848x848px: 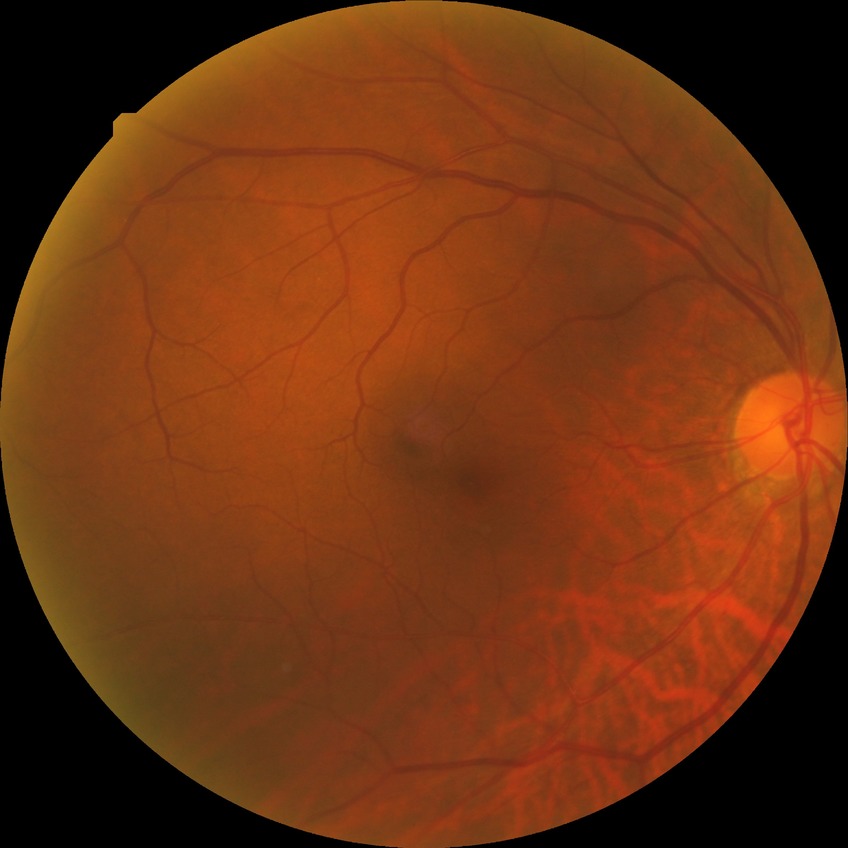 DR is NDR. No signs of diabetic retinopathy.